848 x 848 pixels; color fundus photograph
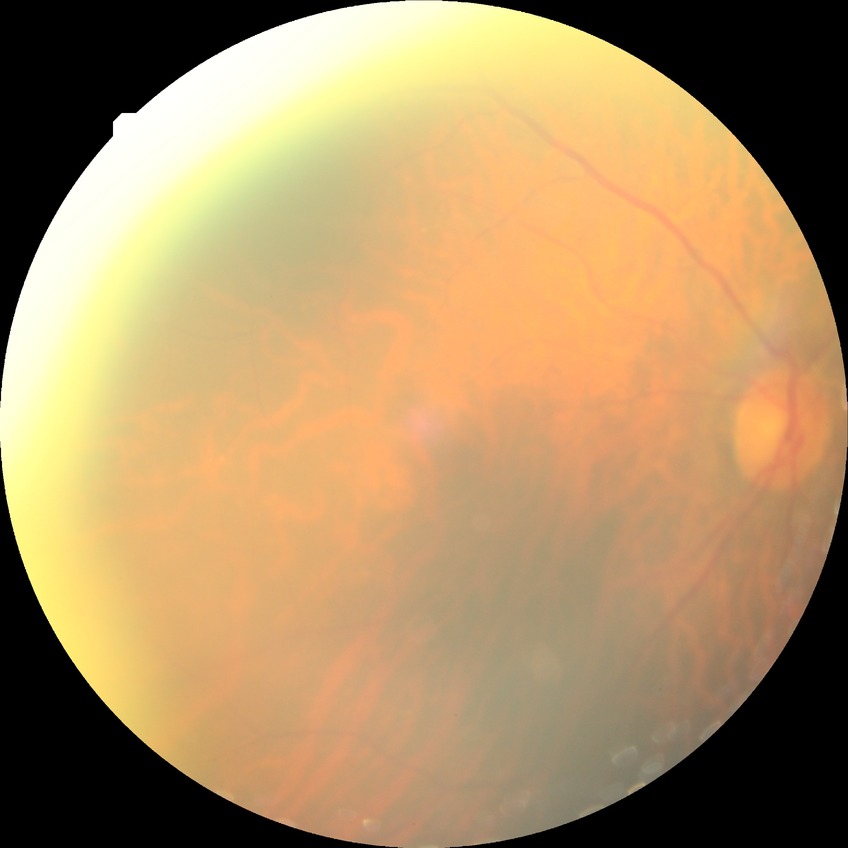
Davis grading: no diabetic retinopathy.